Color fundus photograph:
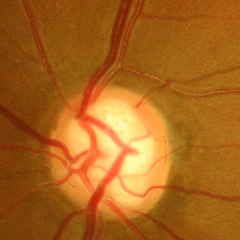 Glaucomatous changes are present. The image shows advanced glaucomatous optic neuropathy.